Captured with the Phoenix ICON (100° field of view). Wide-field fundus photograph from neonatal ROP screening — 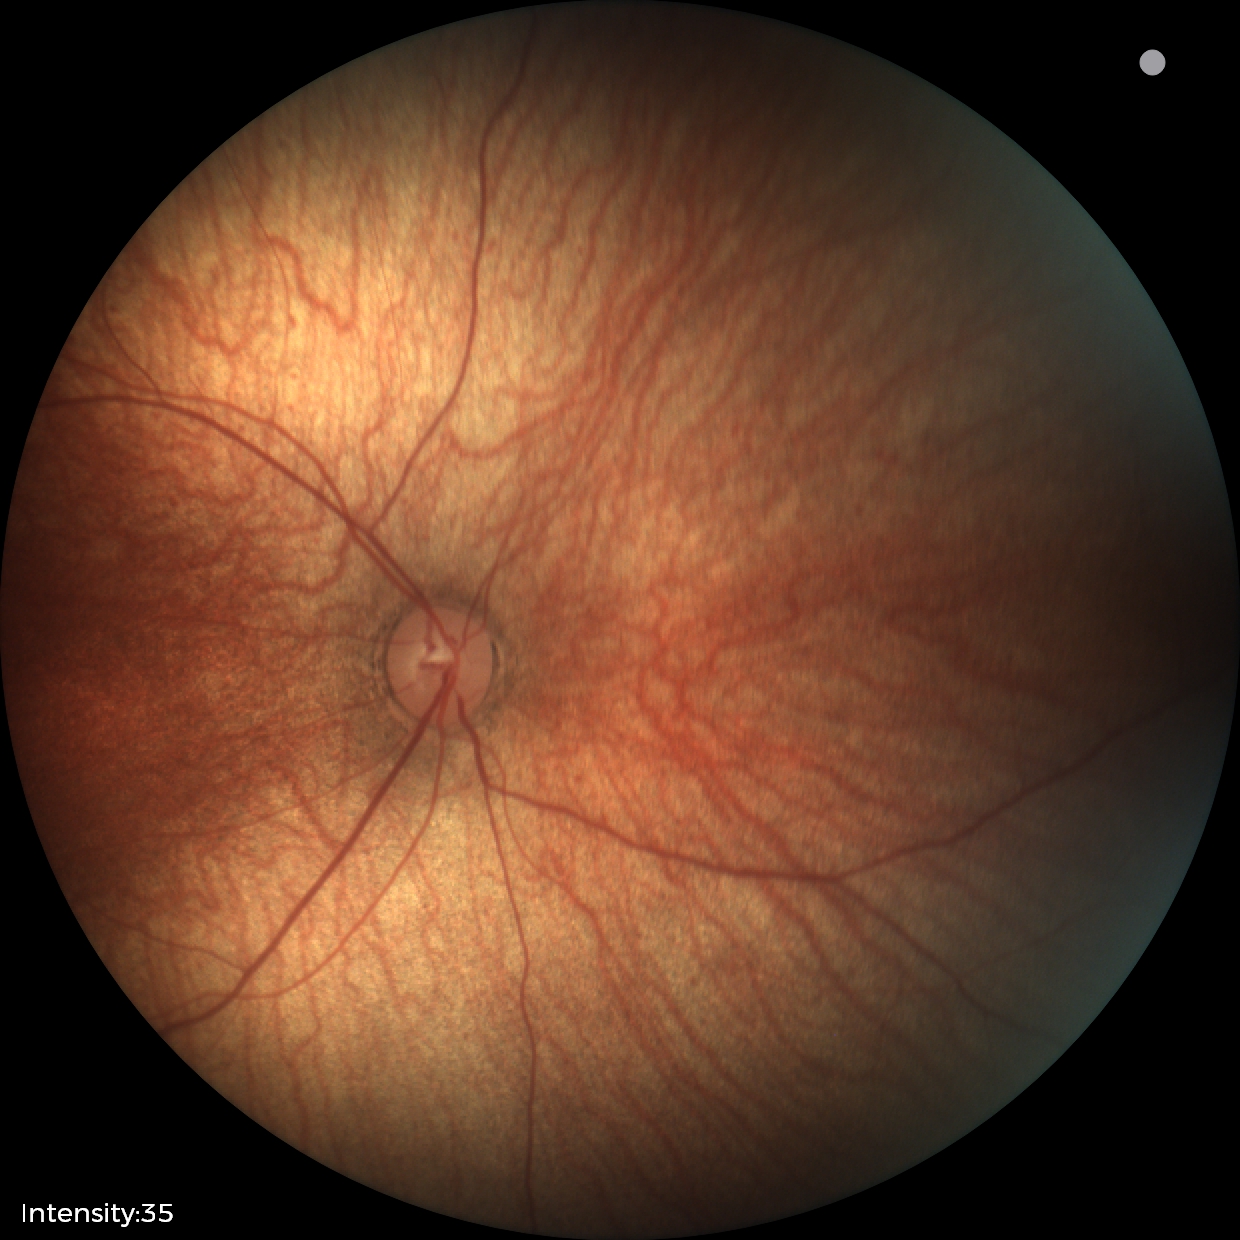

No retinal pathology identified on screening.